Retinal fundus photograph · 1725 x 1721 pixels · 45-degree field of view
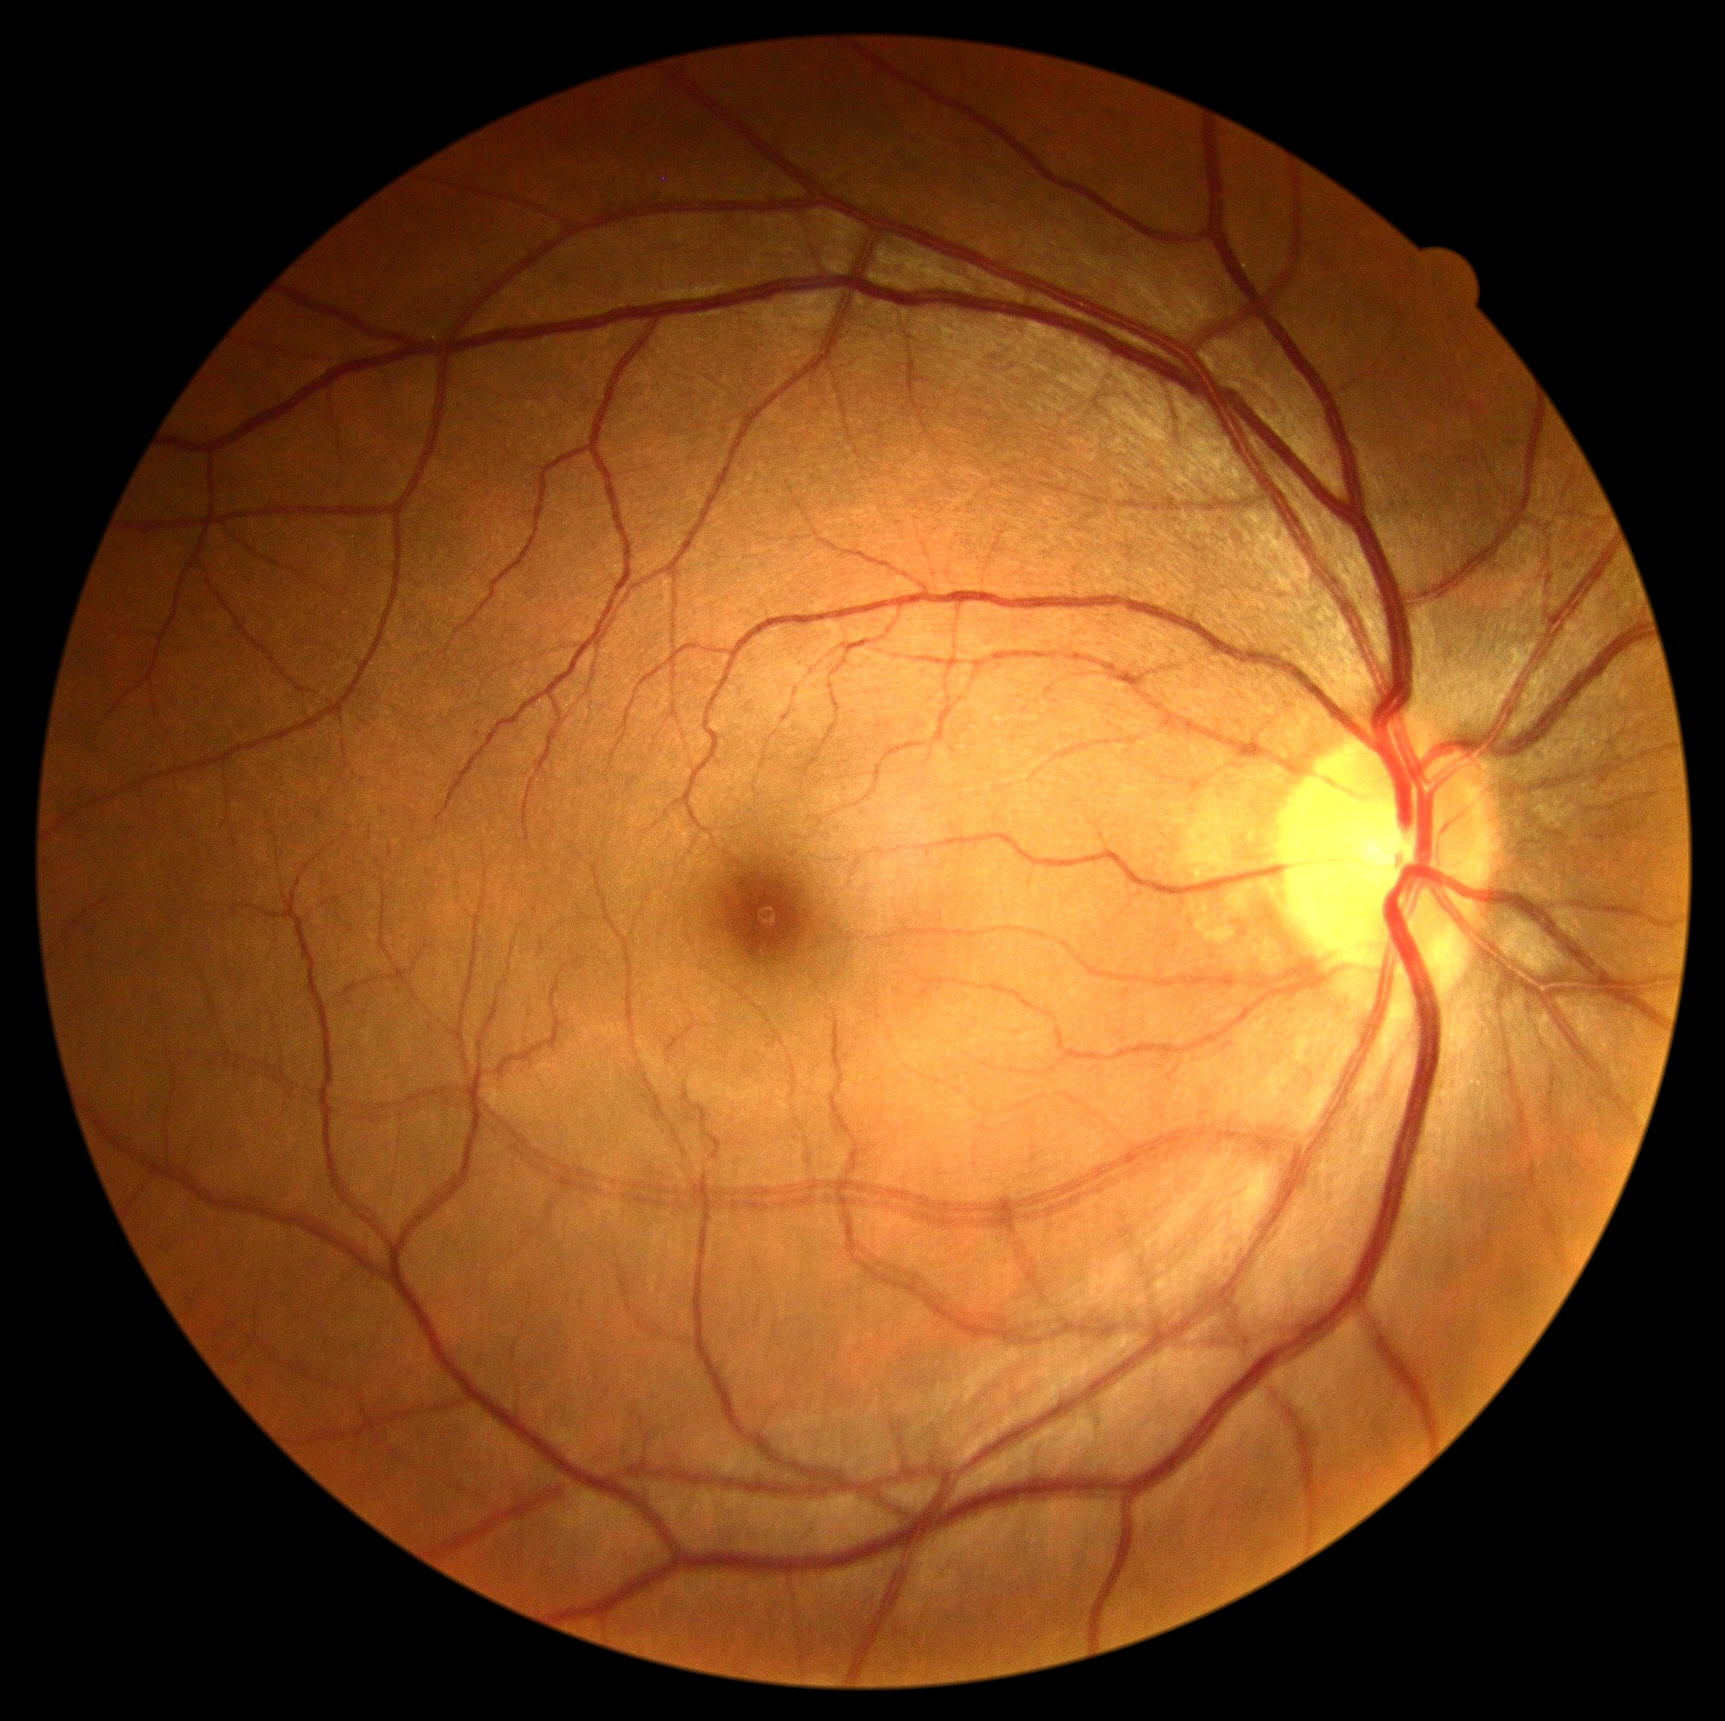 Findings:
- diabetic retinopathy (DR) — 0/4
- DR impression — no signs of DR